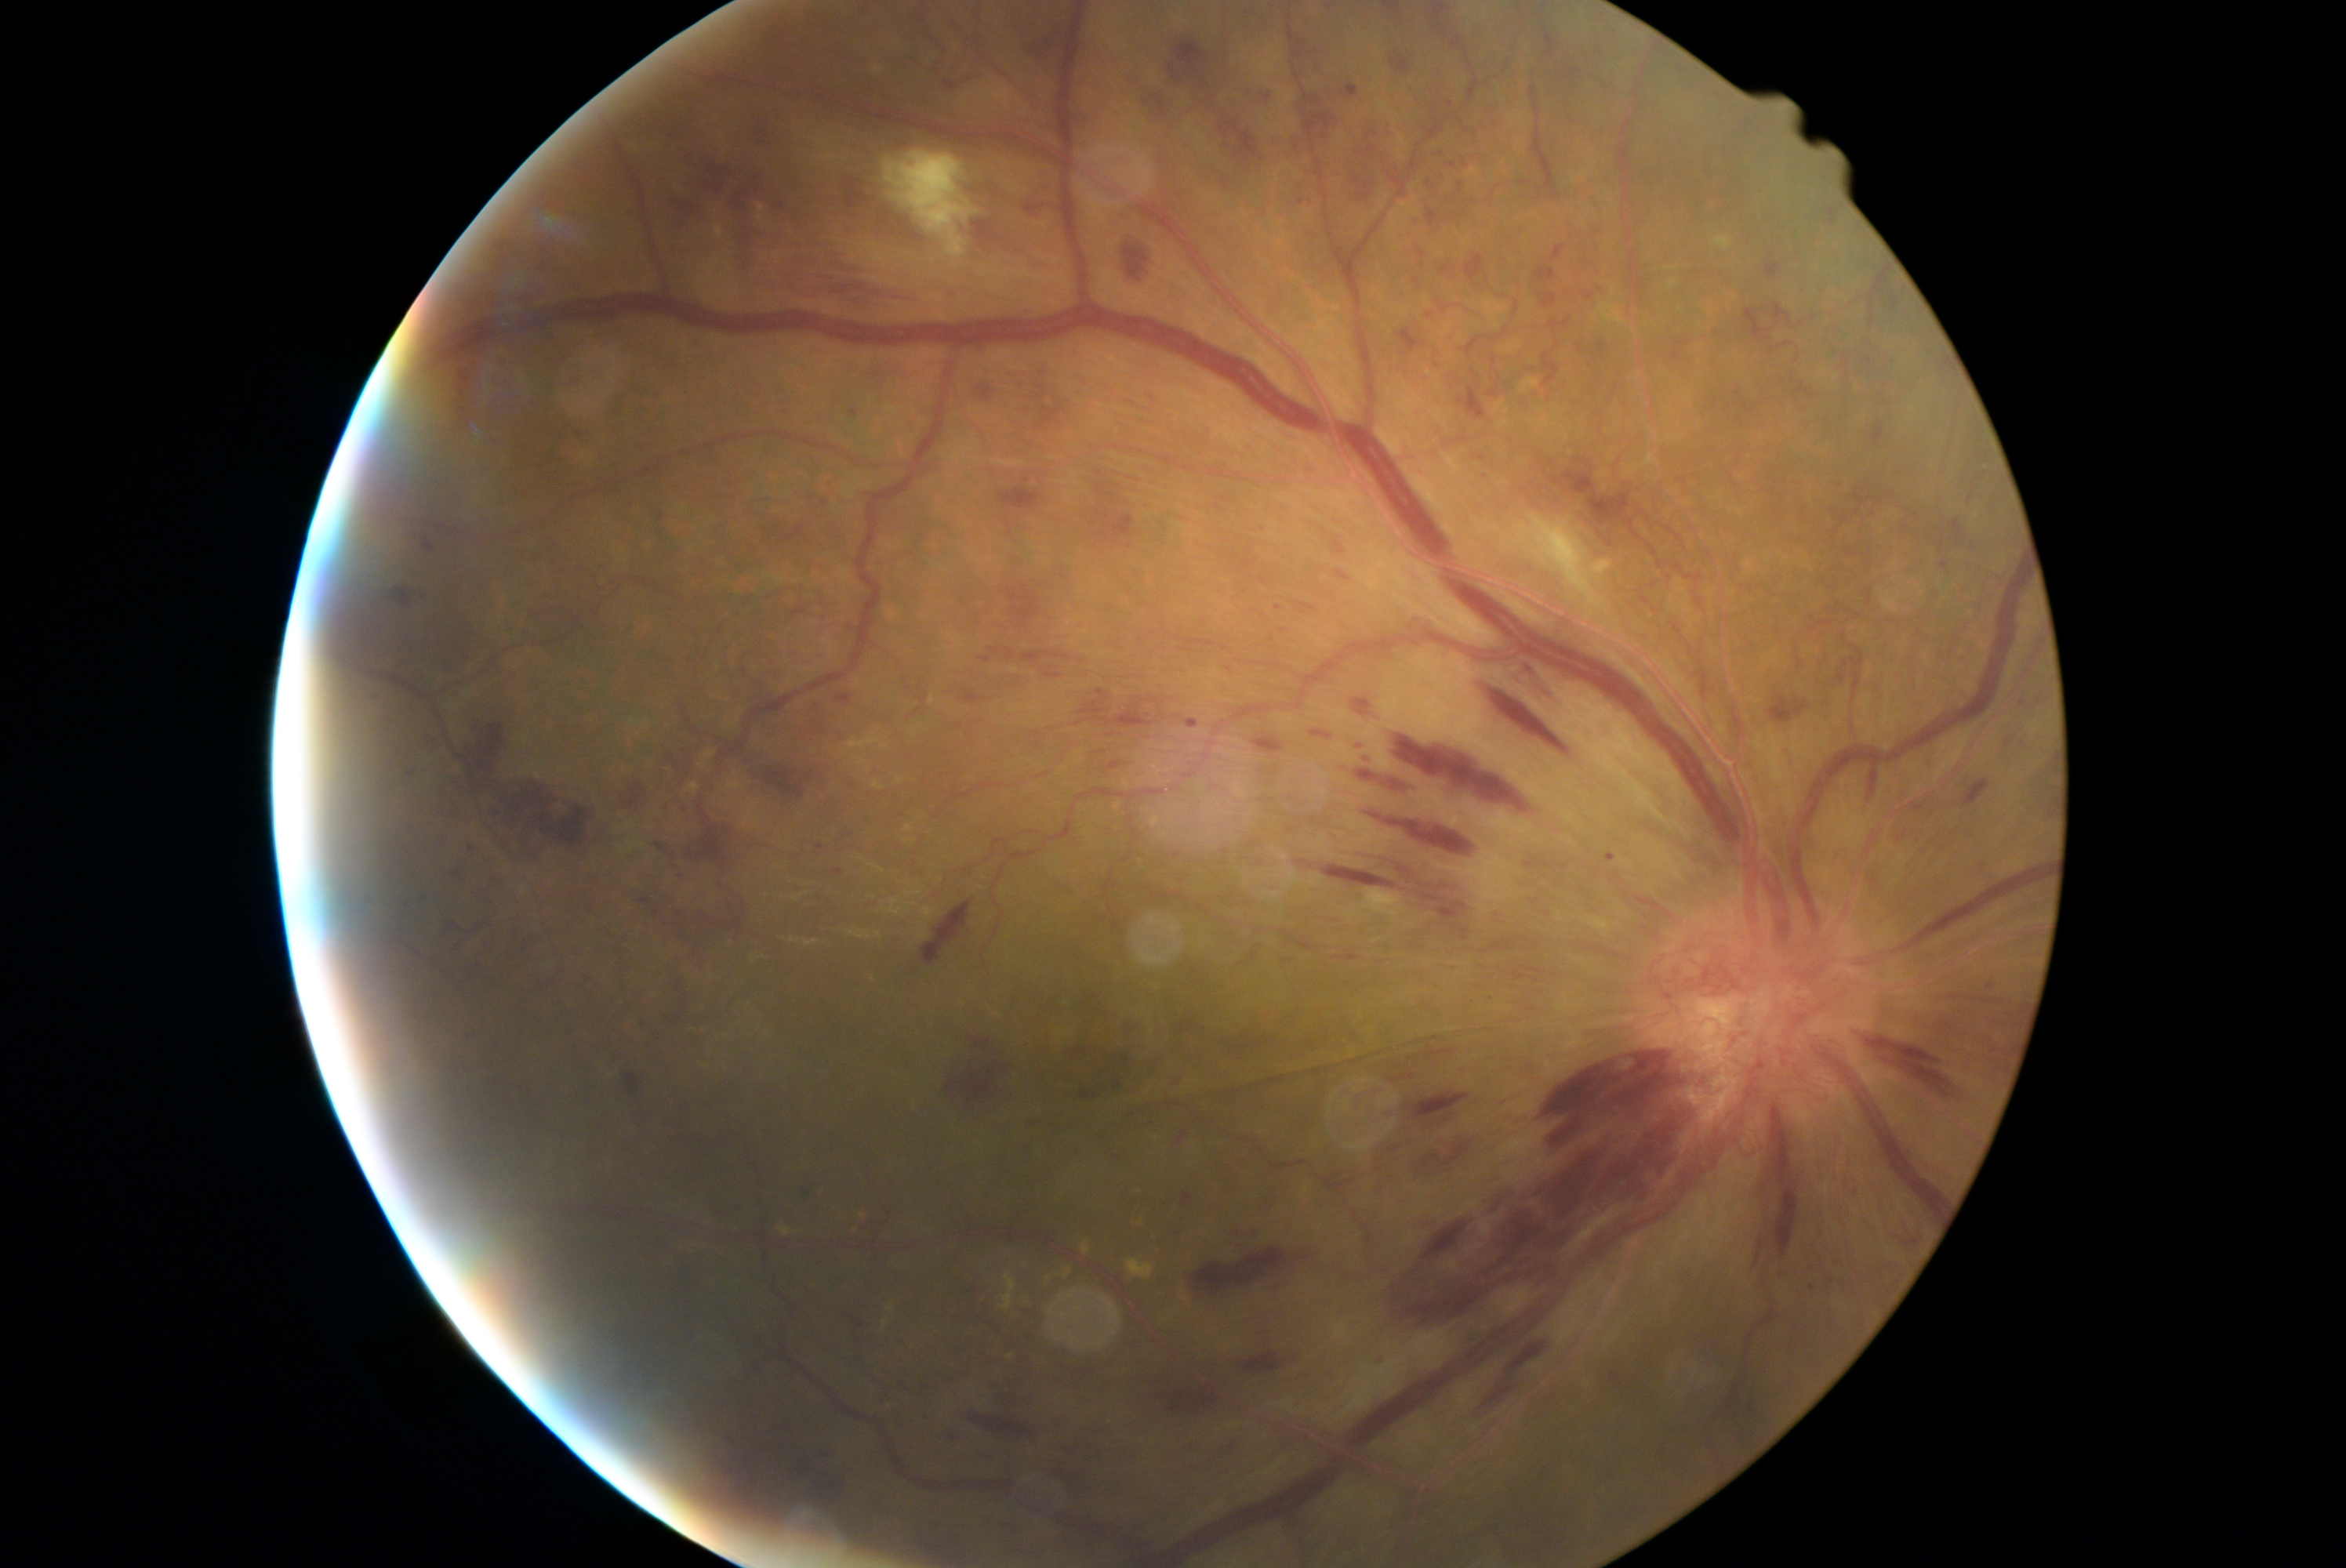
Diabetic retinopathy (DR) is PDR (grade 4)
Lesions identified (partial list):
hemorrhages (HEs) (continued) = rect(1881, 399, 1887, 407); rect(1189, 1246, 1315, 1296); rect(1398, 328, 1428, 352); rect(620, 780, 648, 810); rect(1541, 294, 1558, 308); rect(669, 164, 725, 222); rect(1458, 1203, 1569, 1288); rect(1262, 89, 1273, 106); rect(424, 539, 435, 553); rect(1042, 672, 1075, 683); rect(1865, 357, 1873, 365); rect(1868, 758, 1876, 799); rect(1511, 661, 1564, 703); rect(1778, 1272, 1790, 1280); rect(1152, 1373, 1189, 1385); rect(1062, 1464, 1100, 1495); rect(1442, 266, 1458, 274); rect(971, 1414, 1034, 1437)
Additional small HEs near [2053, 805]; [1814, 1244]